Topcon TRC-50DX, retinal fundus photograph
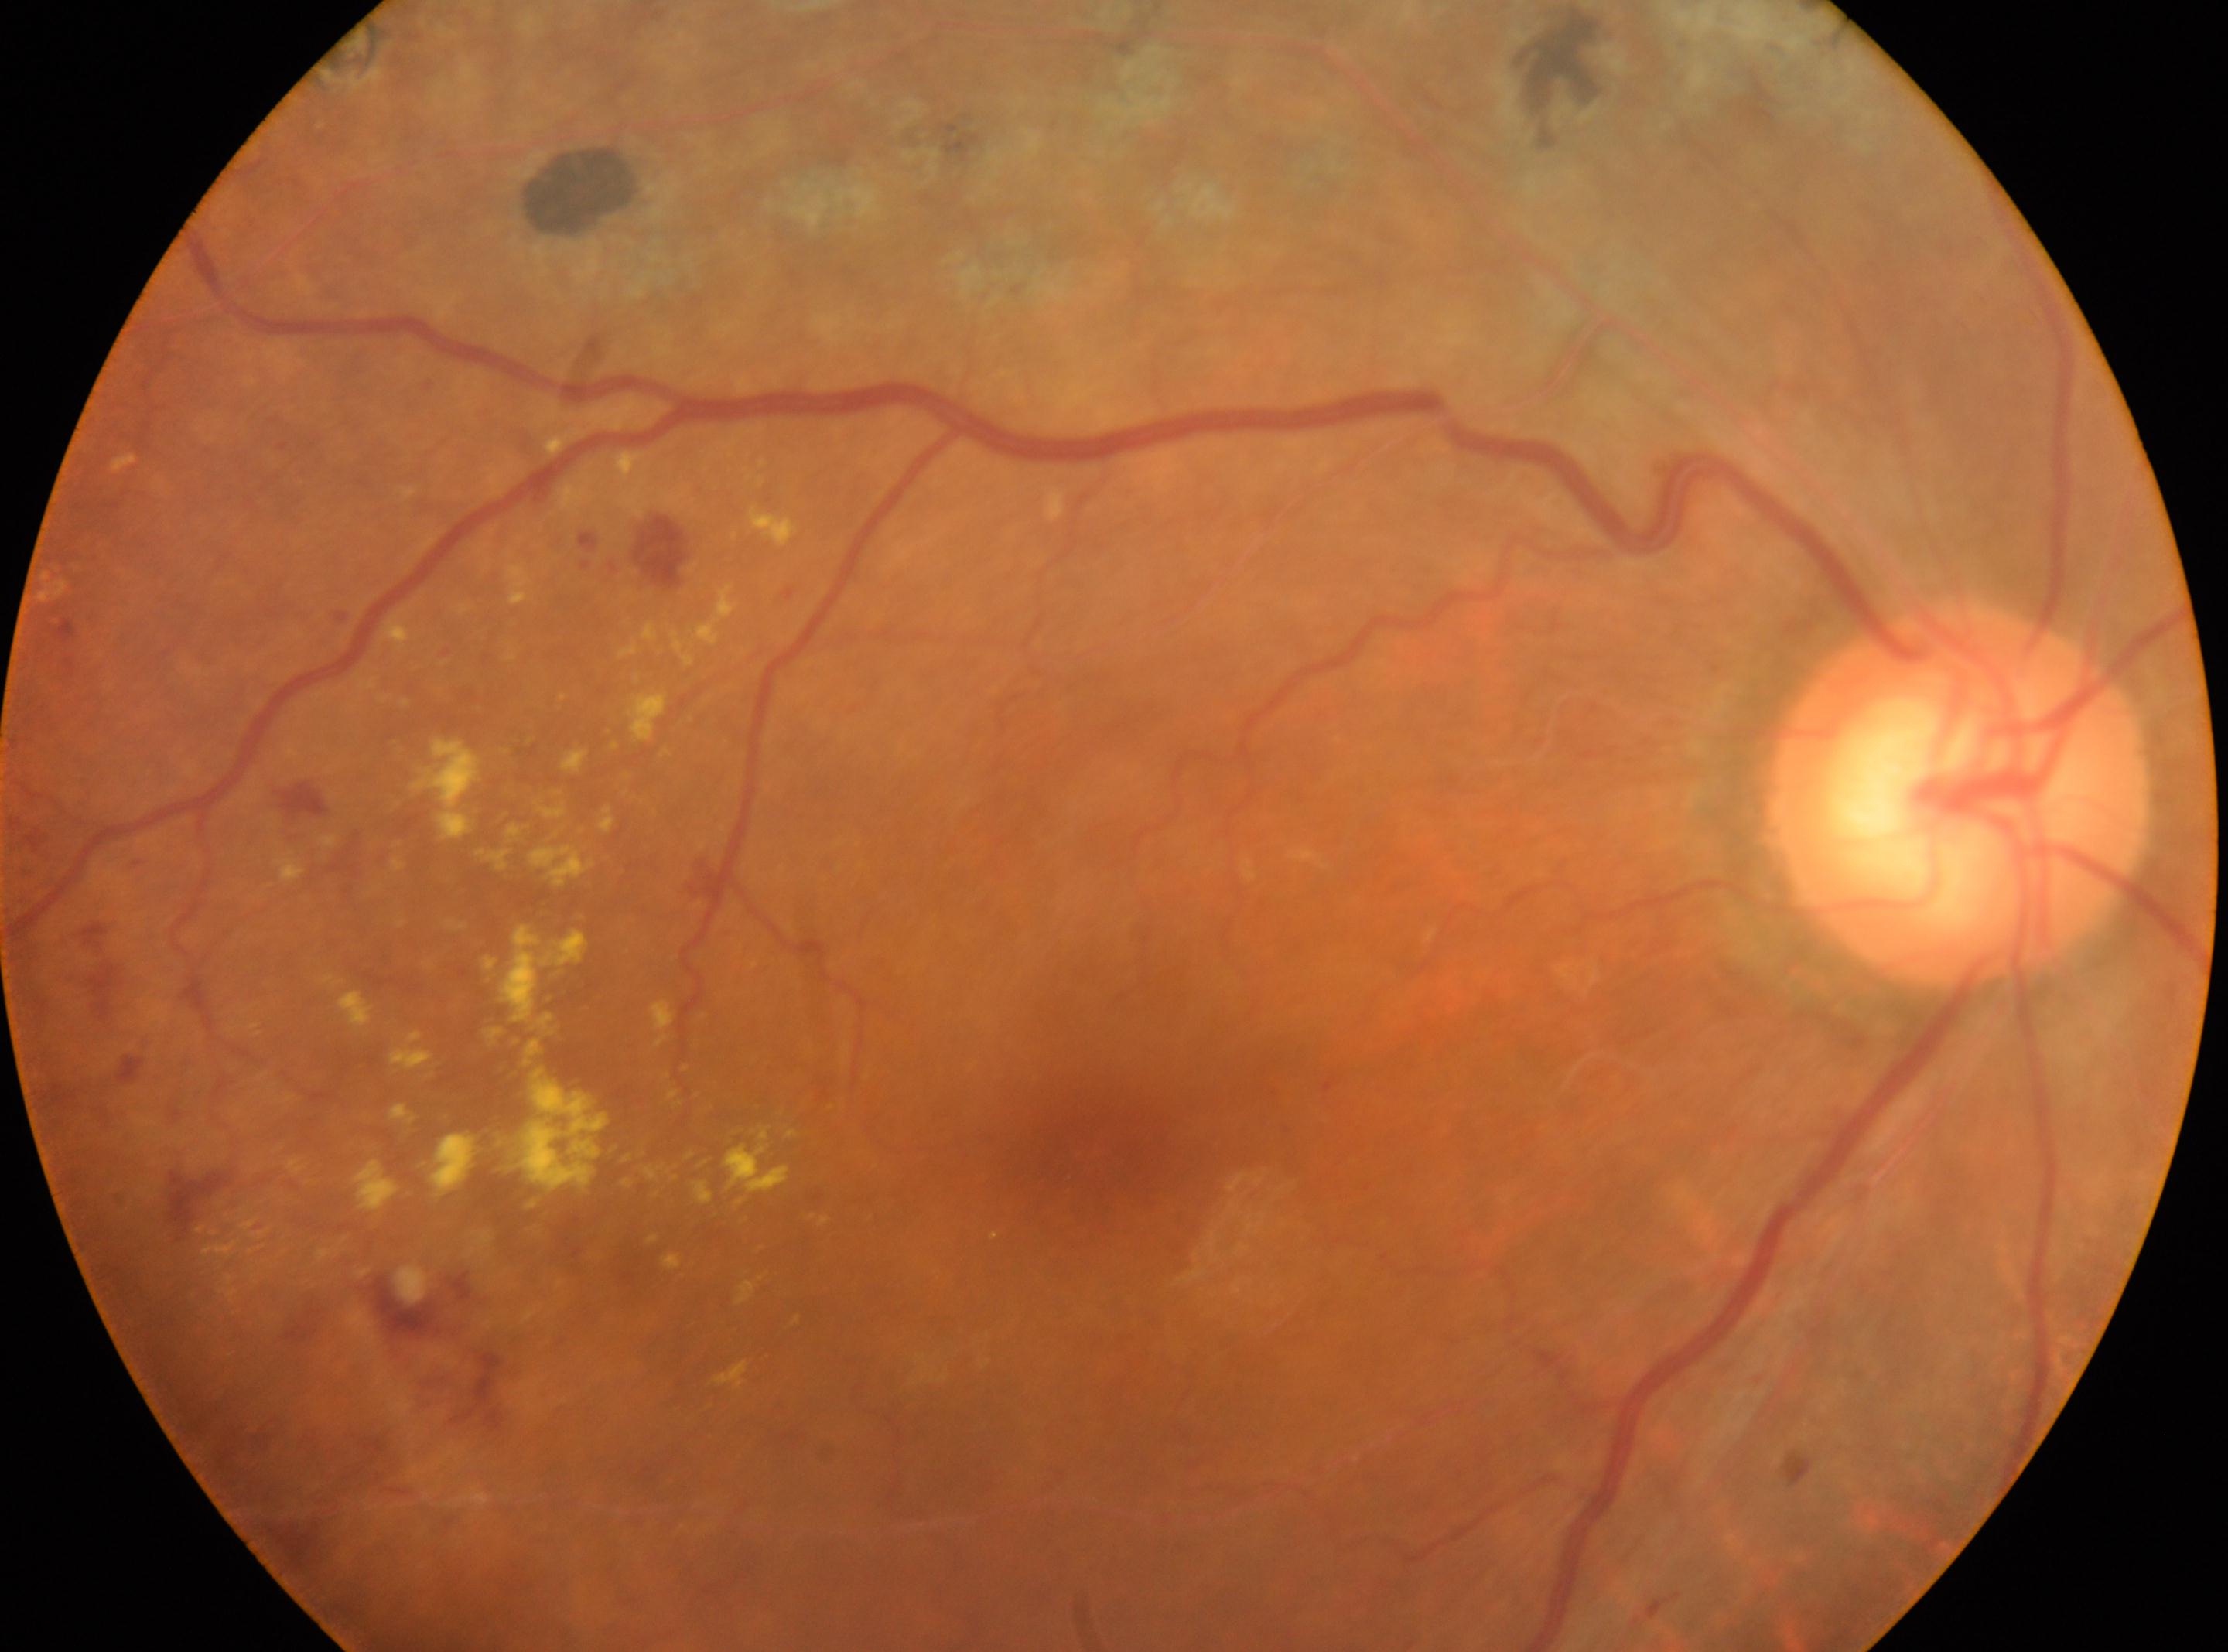
This is the oculus dexter.
The macular center is at (x=1083, y=1155).
The optic disc center is at (x=1959, y=798).
Diabetic retinopathy grade is post-photocoagulation DR.